2352 by 1568 pixels
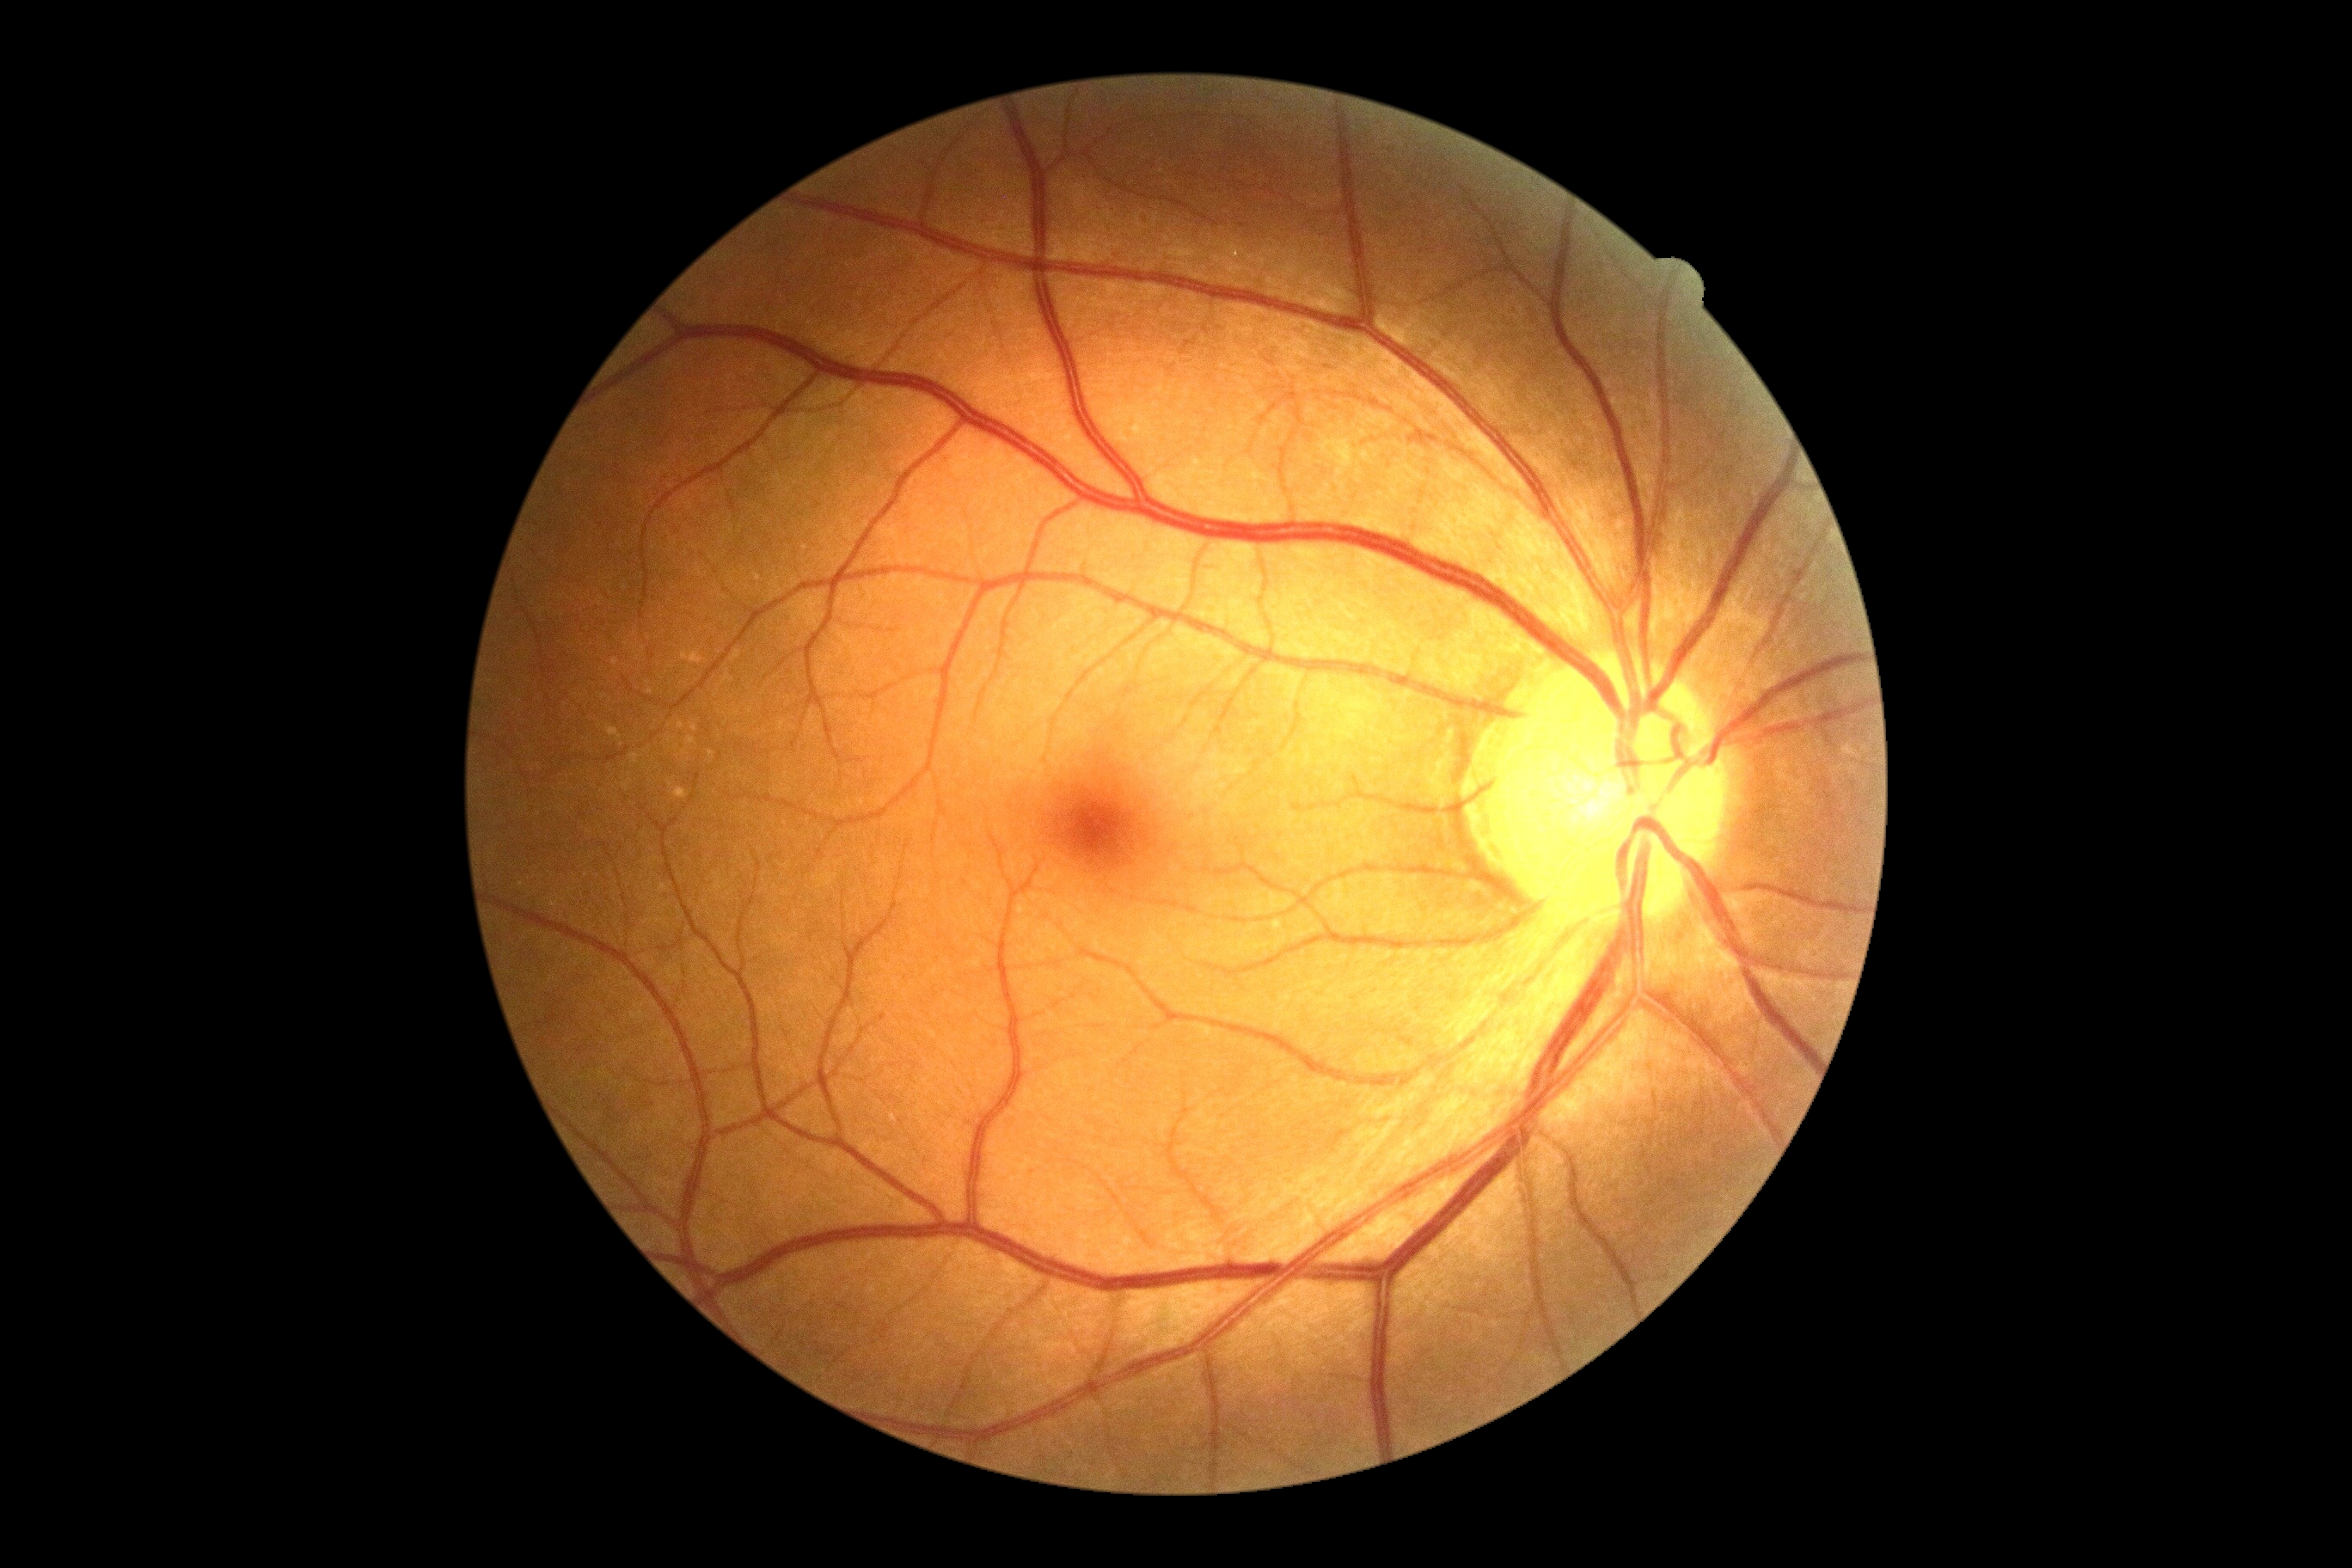

DR: 0.